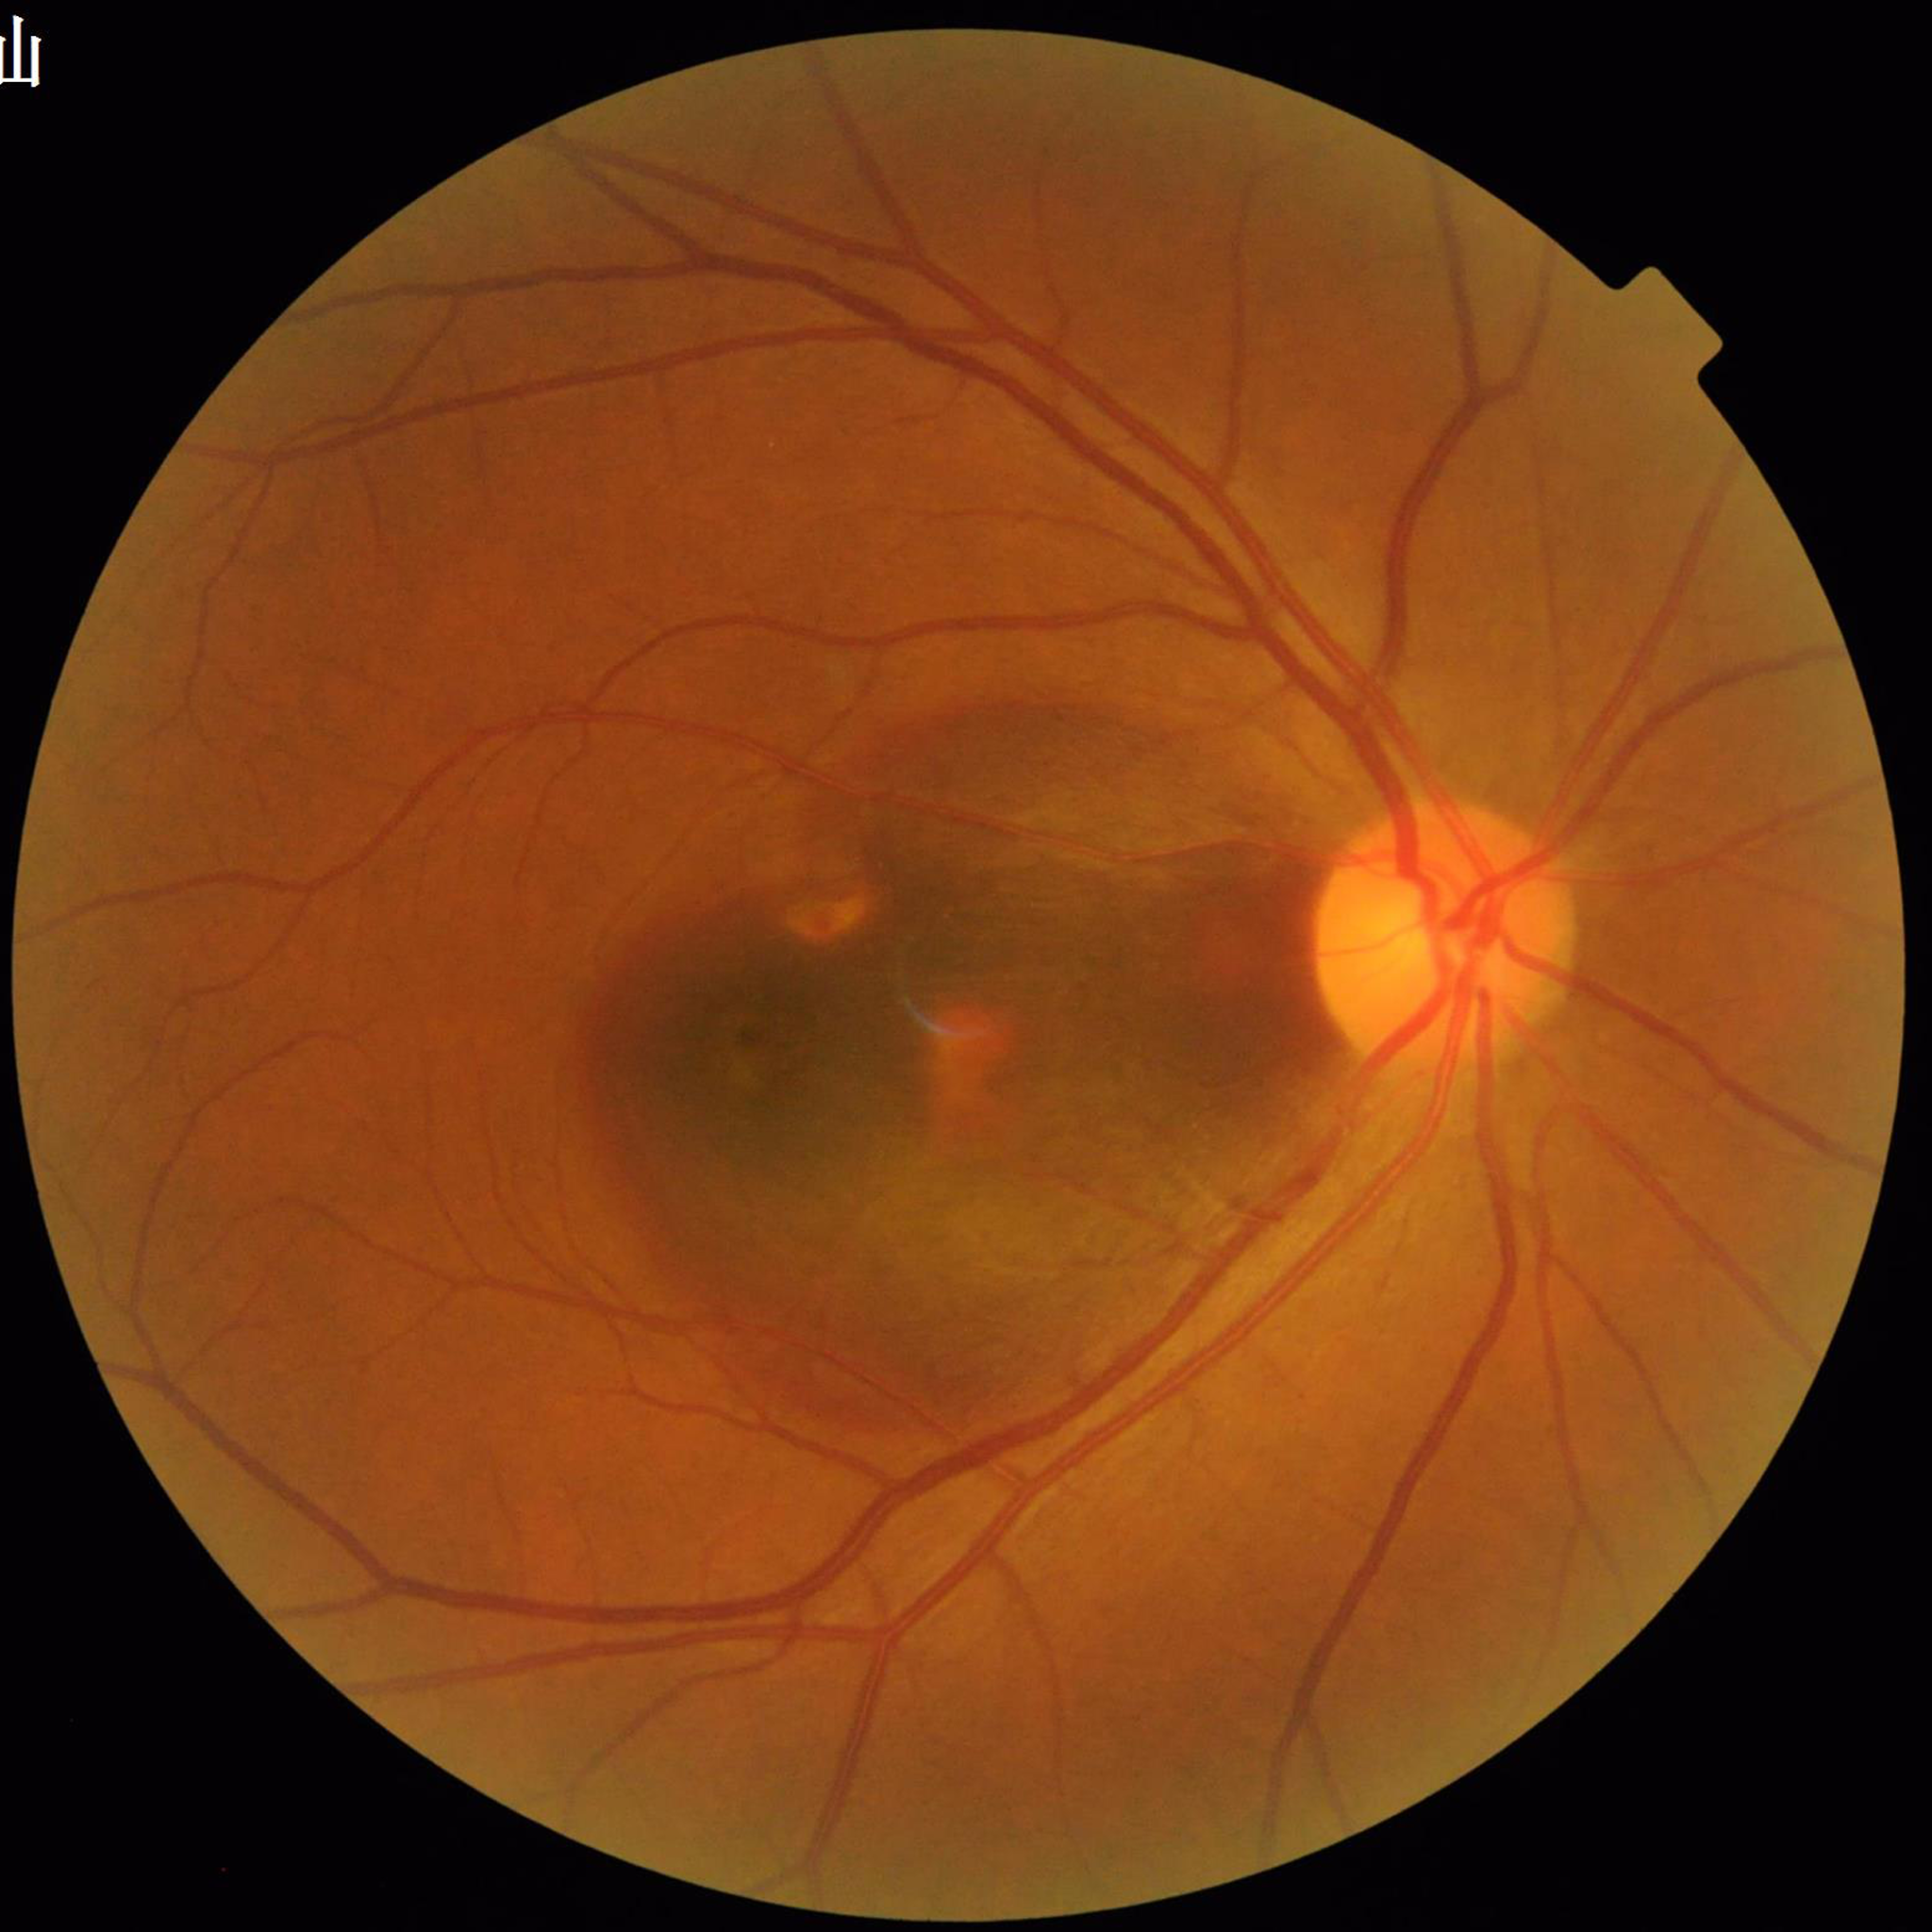
Color fundus photograph from a patient diagnosed with age-related macular degeneration.